NIDEK AFC-230 · nonmydriatic fundus photograph · posterior pole color fundus photograph
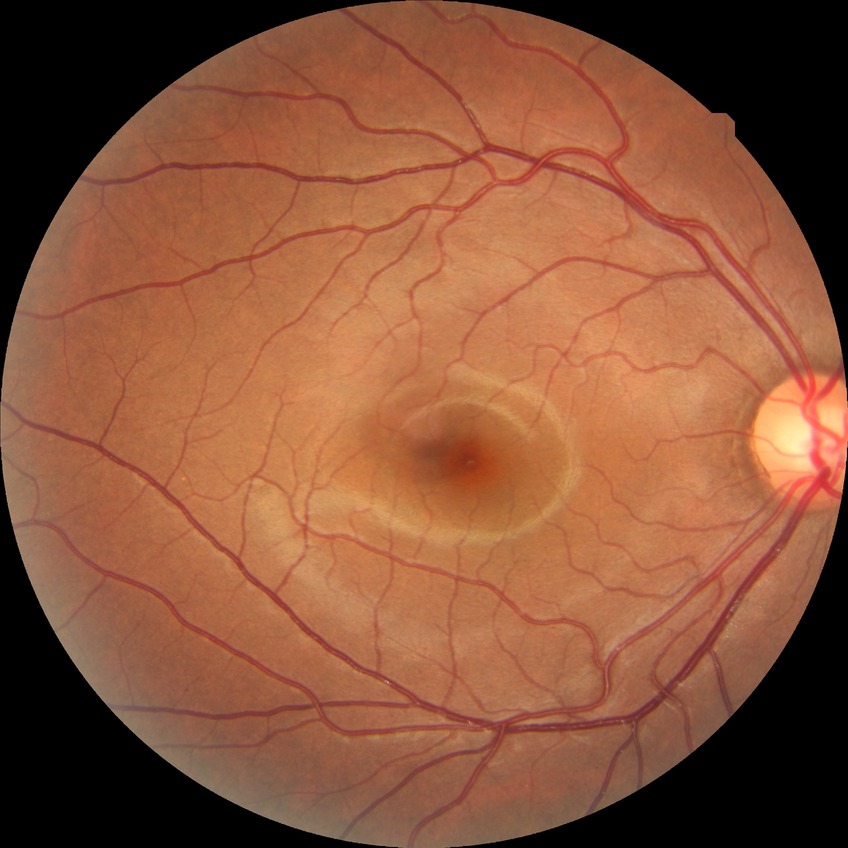 Assessment:
– diabetic retinopathy (DR): no diabetic retinopathy (NDR)